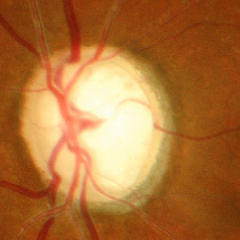

Advanced glaucoma.
Diagnostic criteria: near-total cupping of the optic nerve head, with or without severe visual field loss within the central 10 degrees of fixation.